45° field of view.
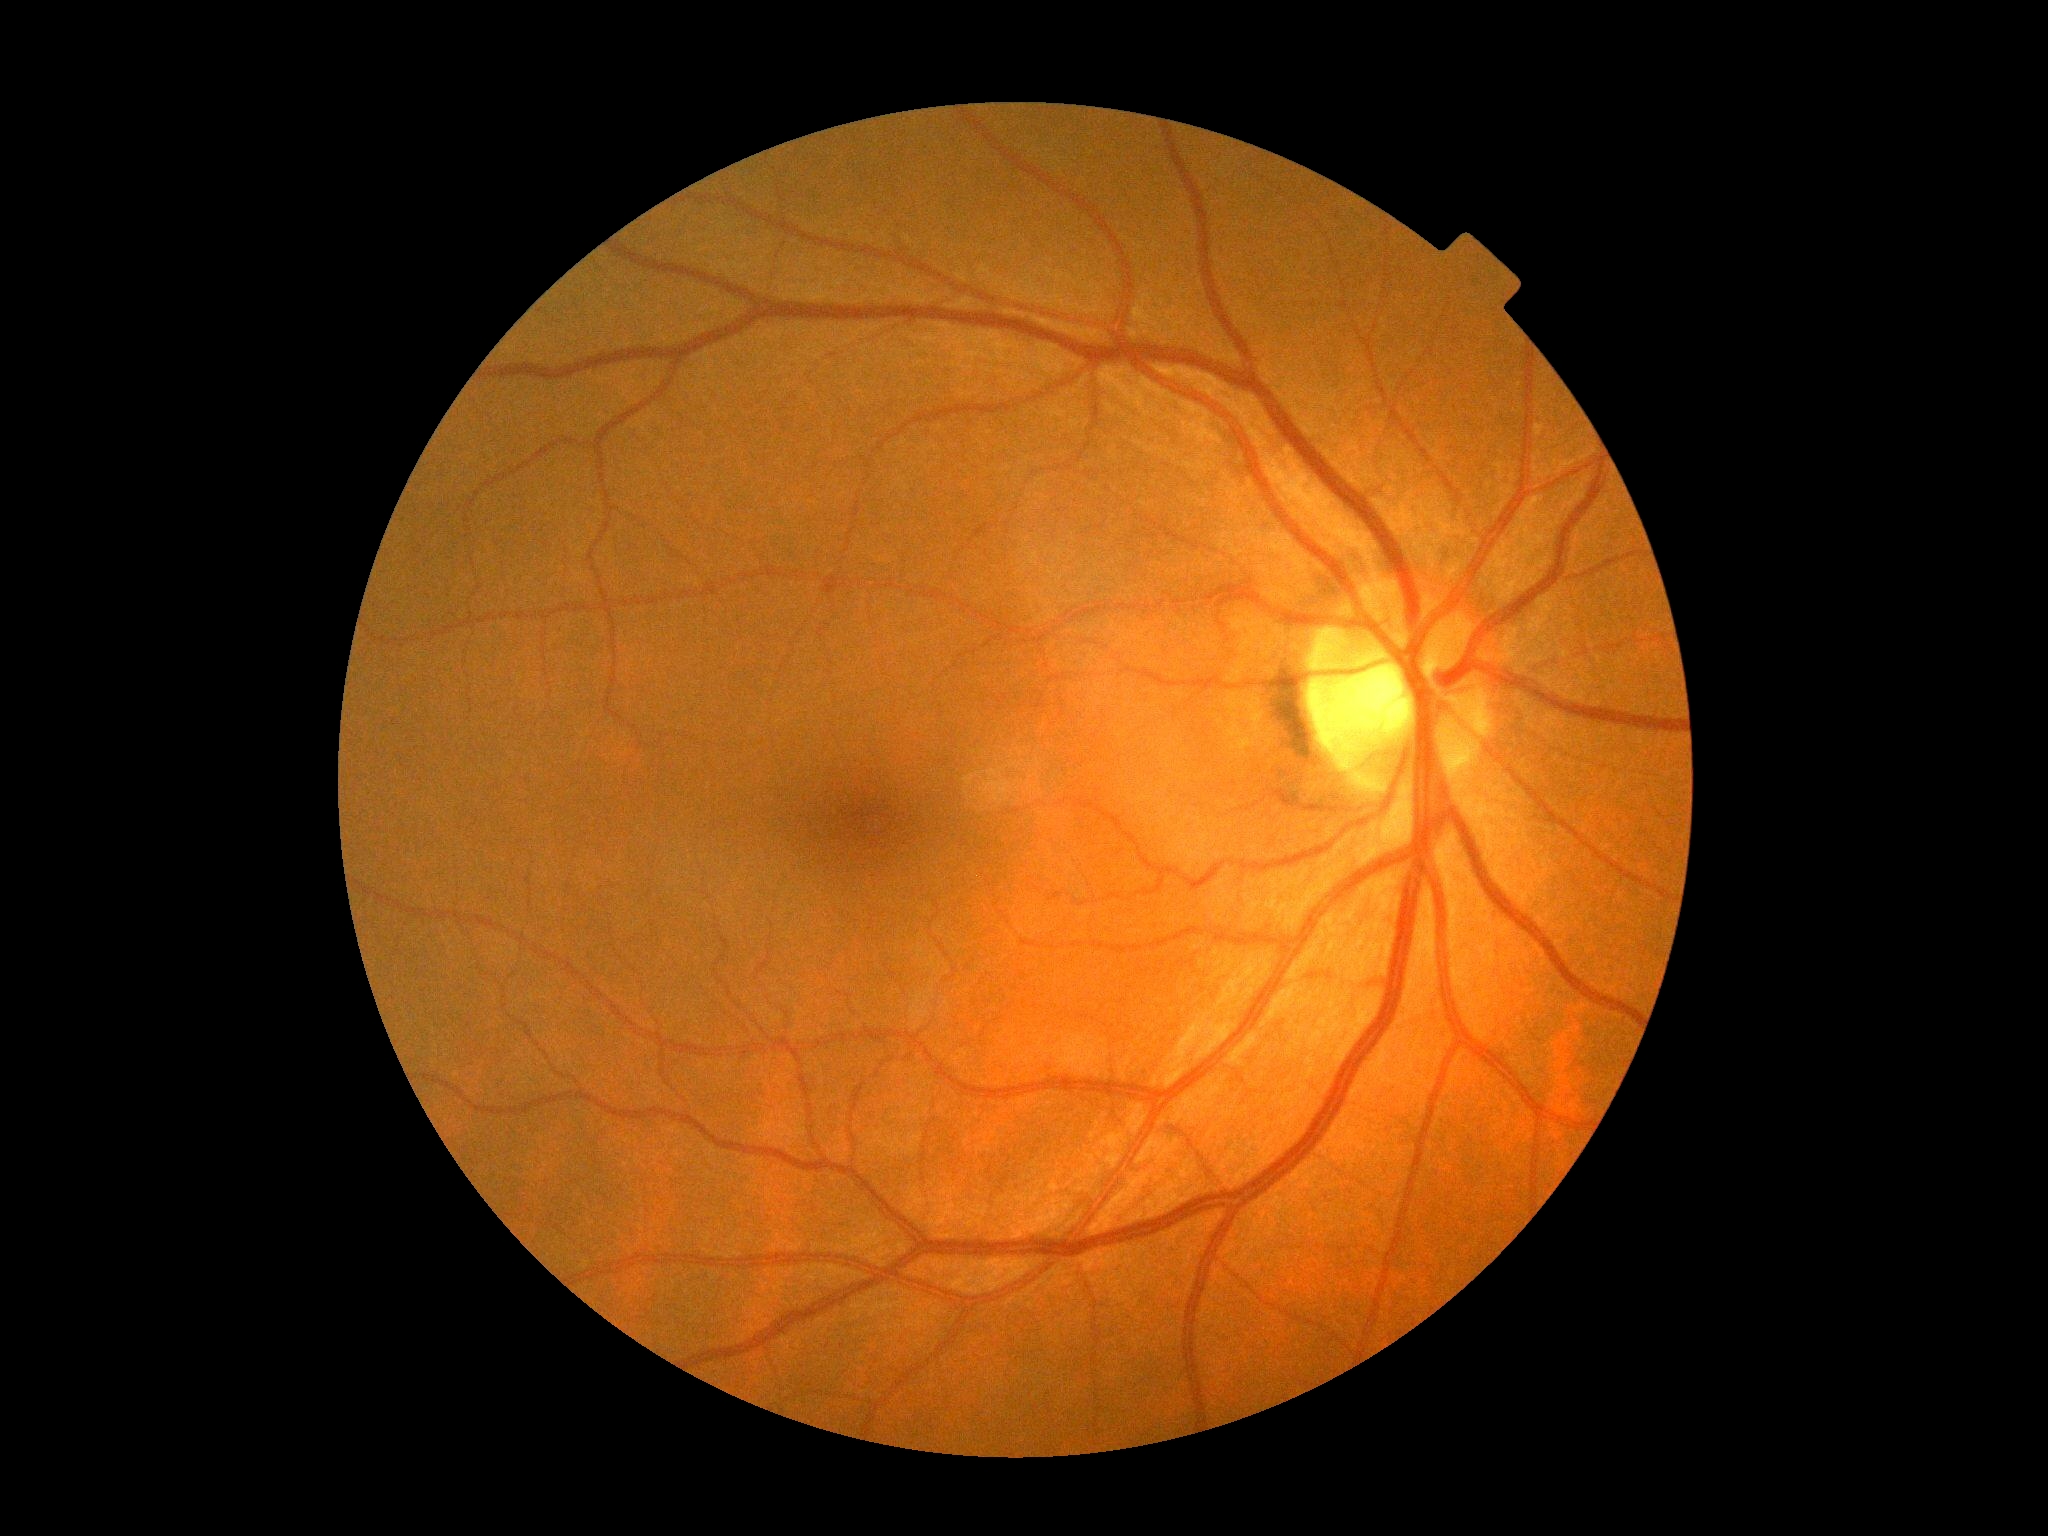
Findings:
• DR impression: no DR findings
• retinopathy: grade 0 (no apparent retinopathy)